2212 by 1659 pixels, 45-degree field of view:
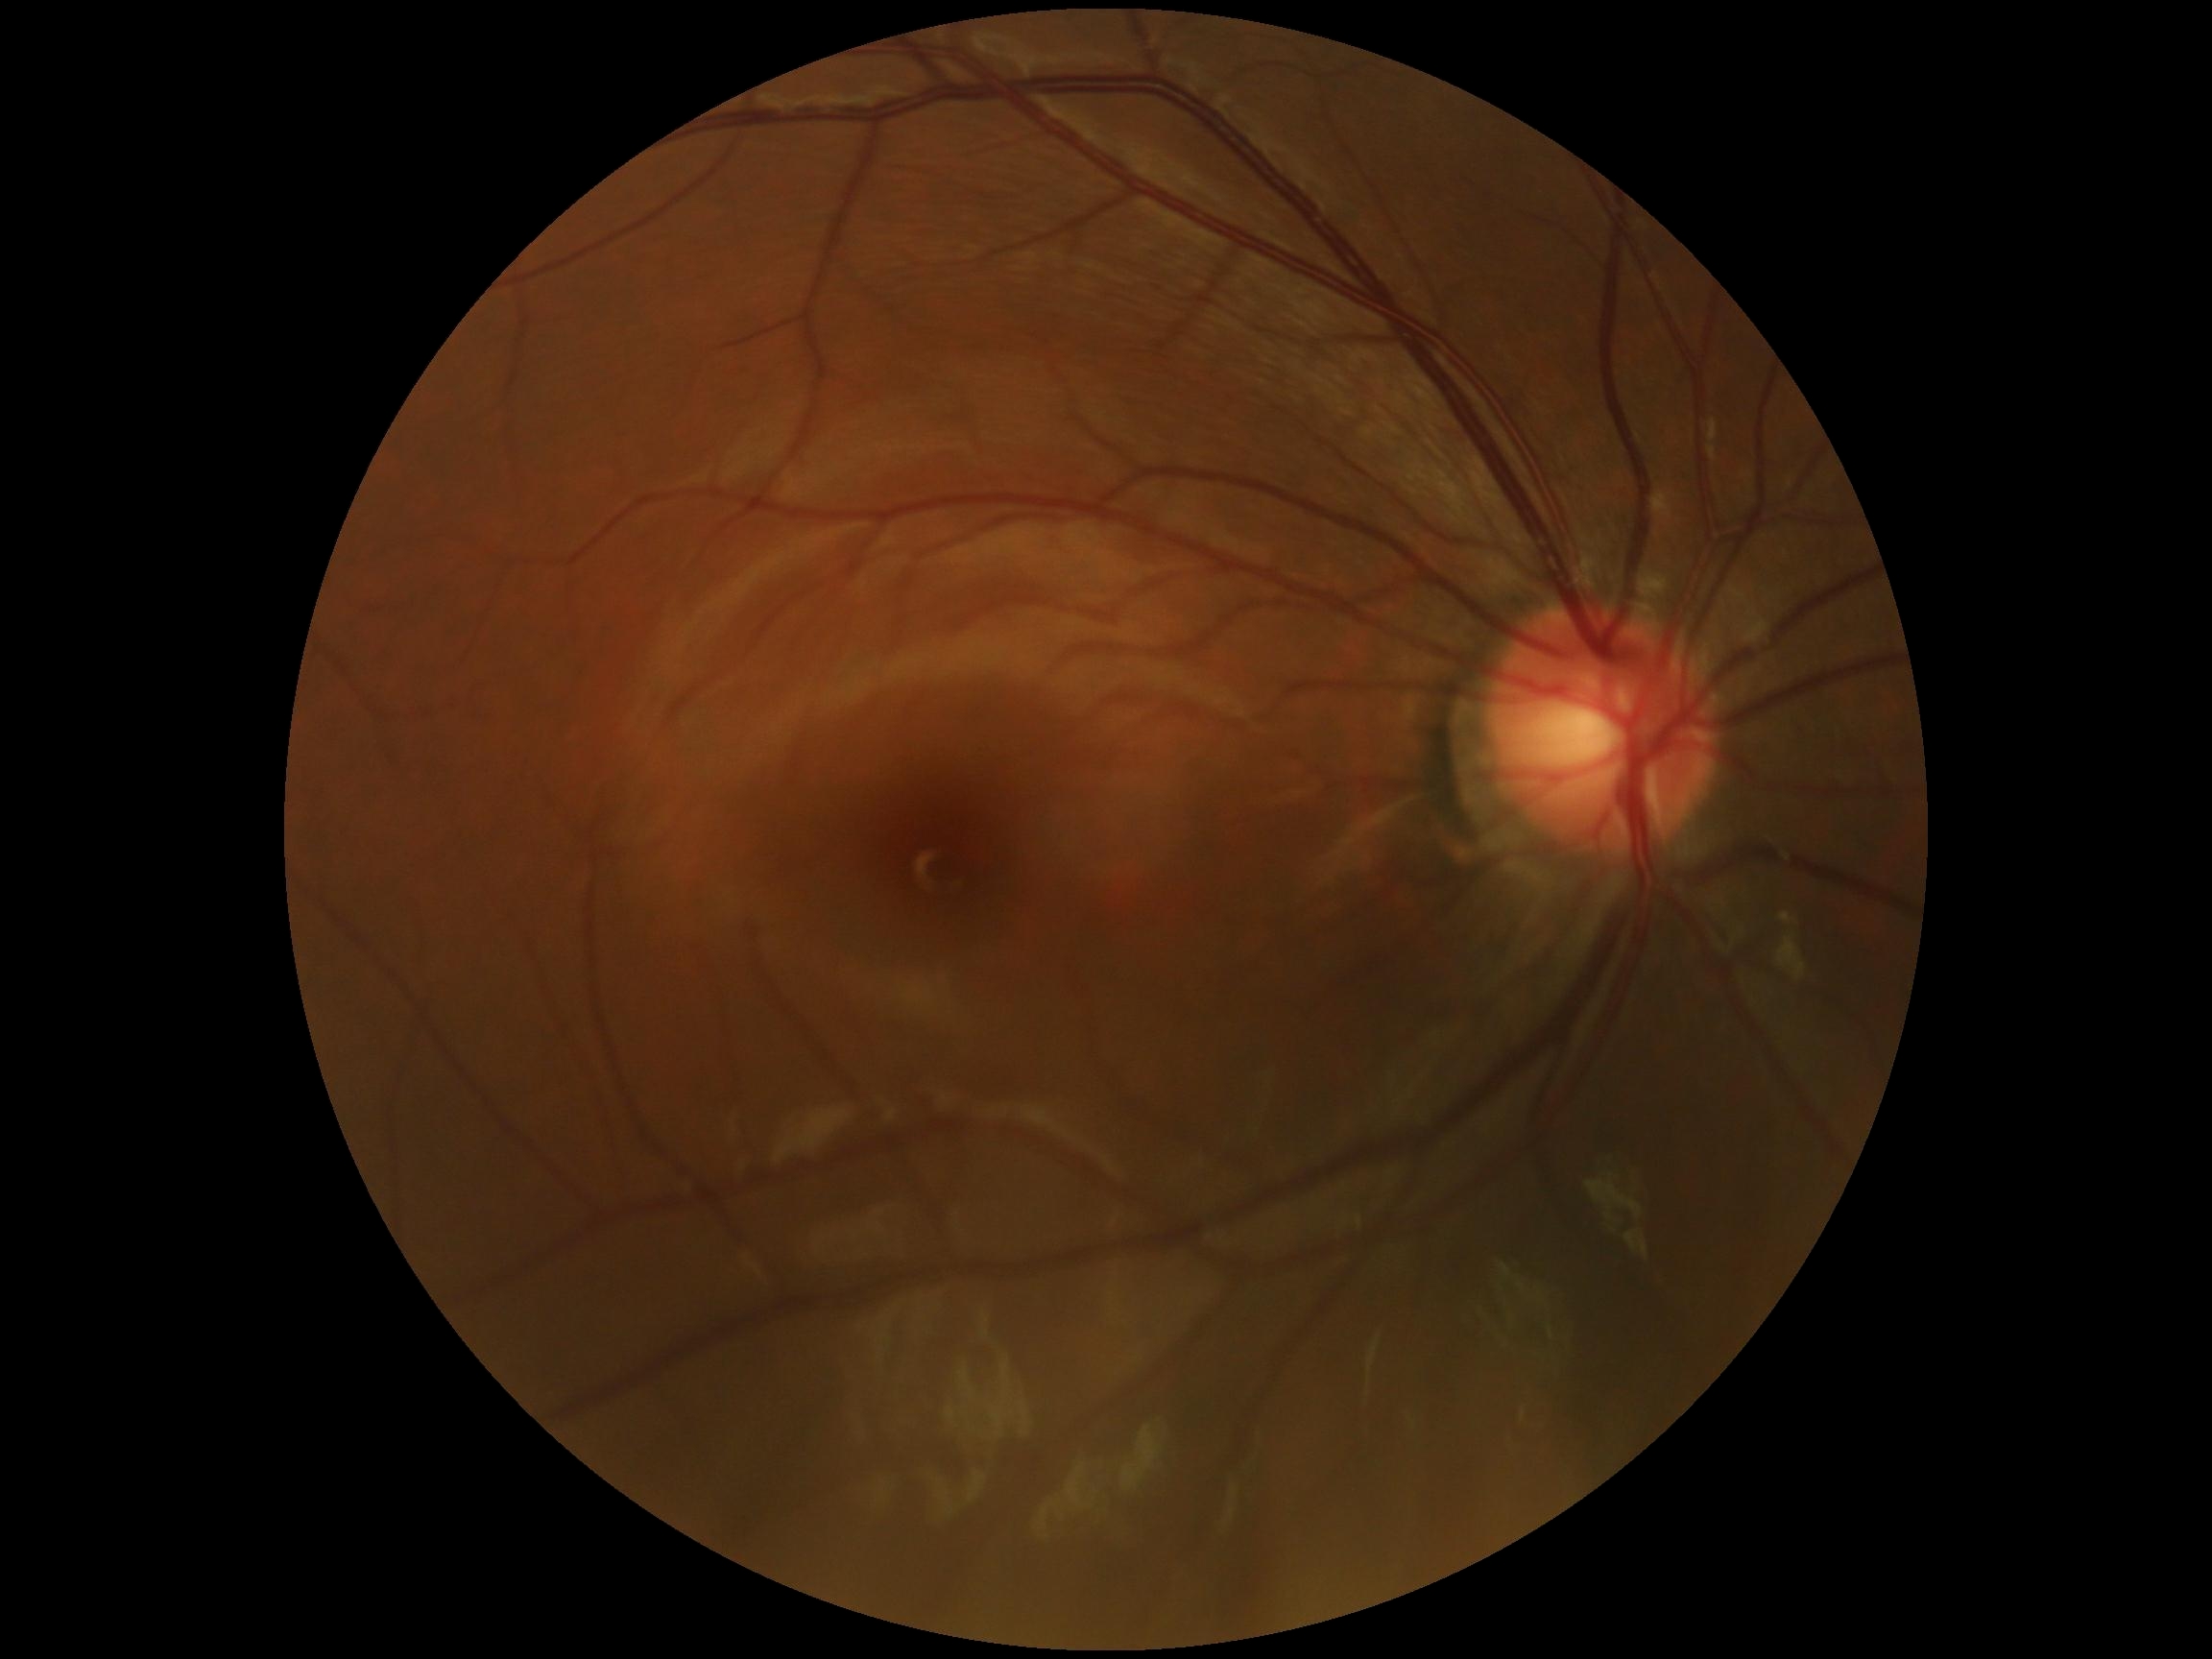 DR stage: no apparent diabetic retinopathy (grade 0).